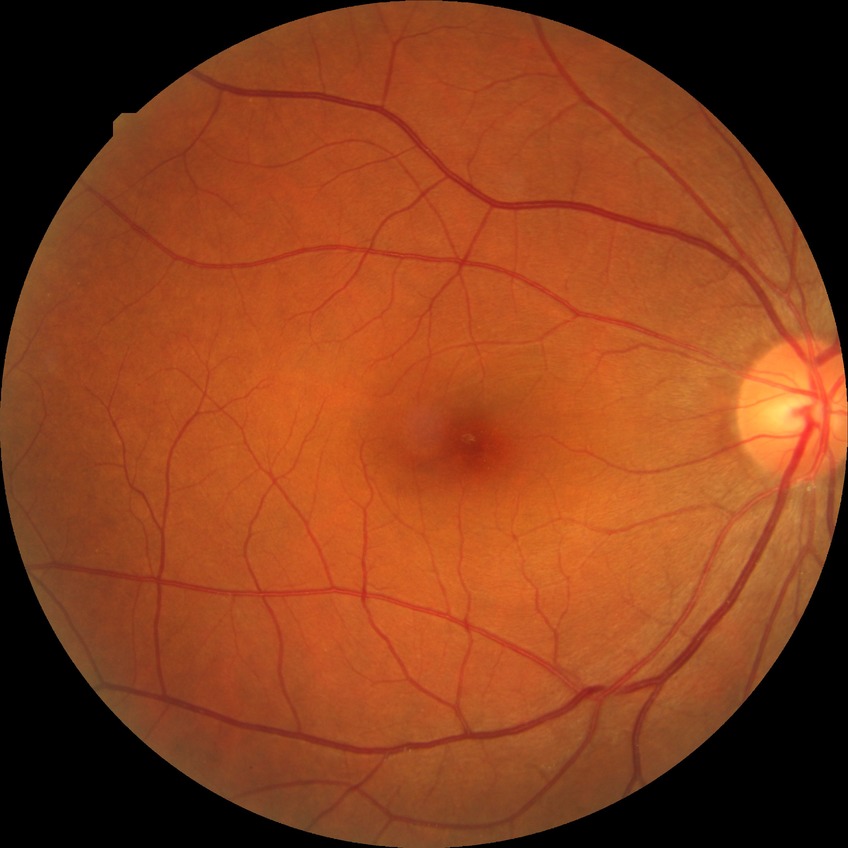

Diabetic retinopathy (DR) is NDR (no diabetic retinopathy).